Image size 1932x1916; FOV: 45 degrees.
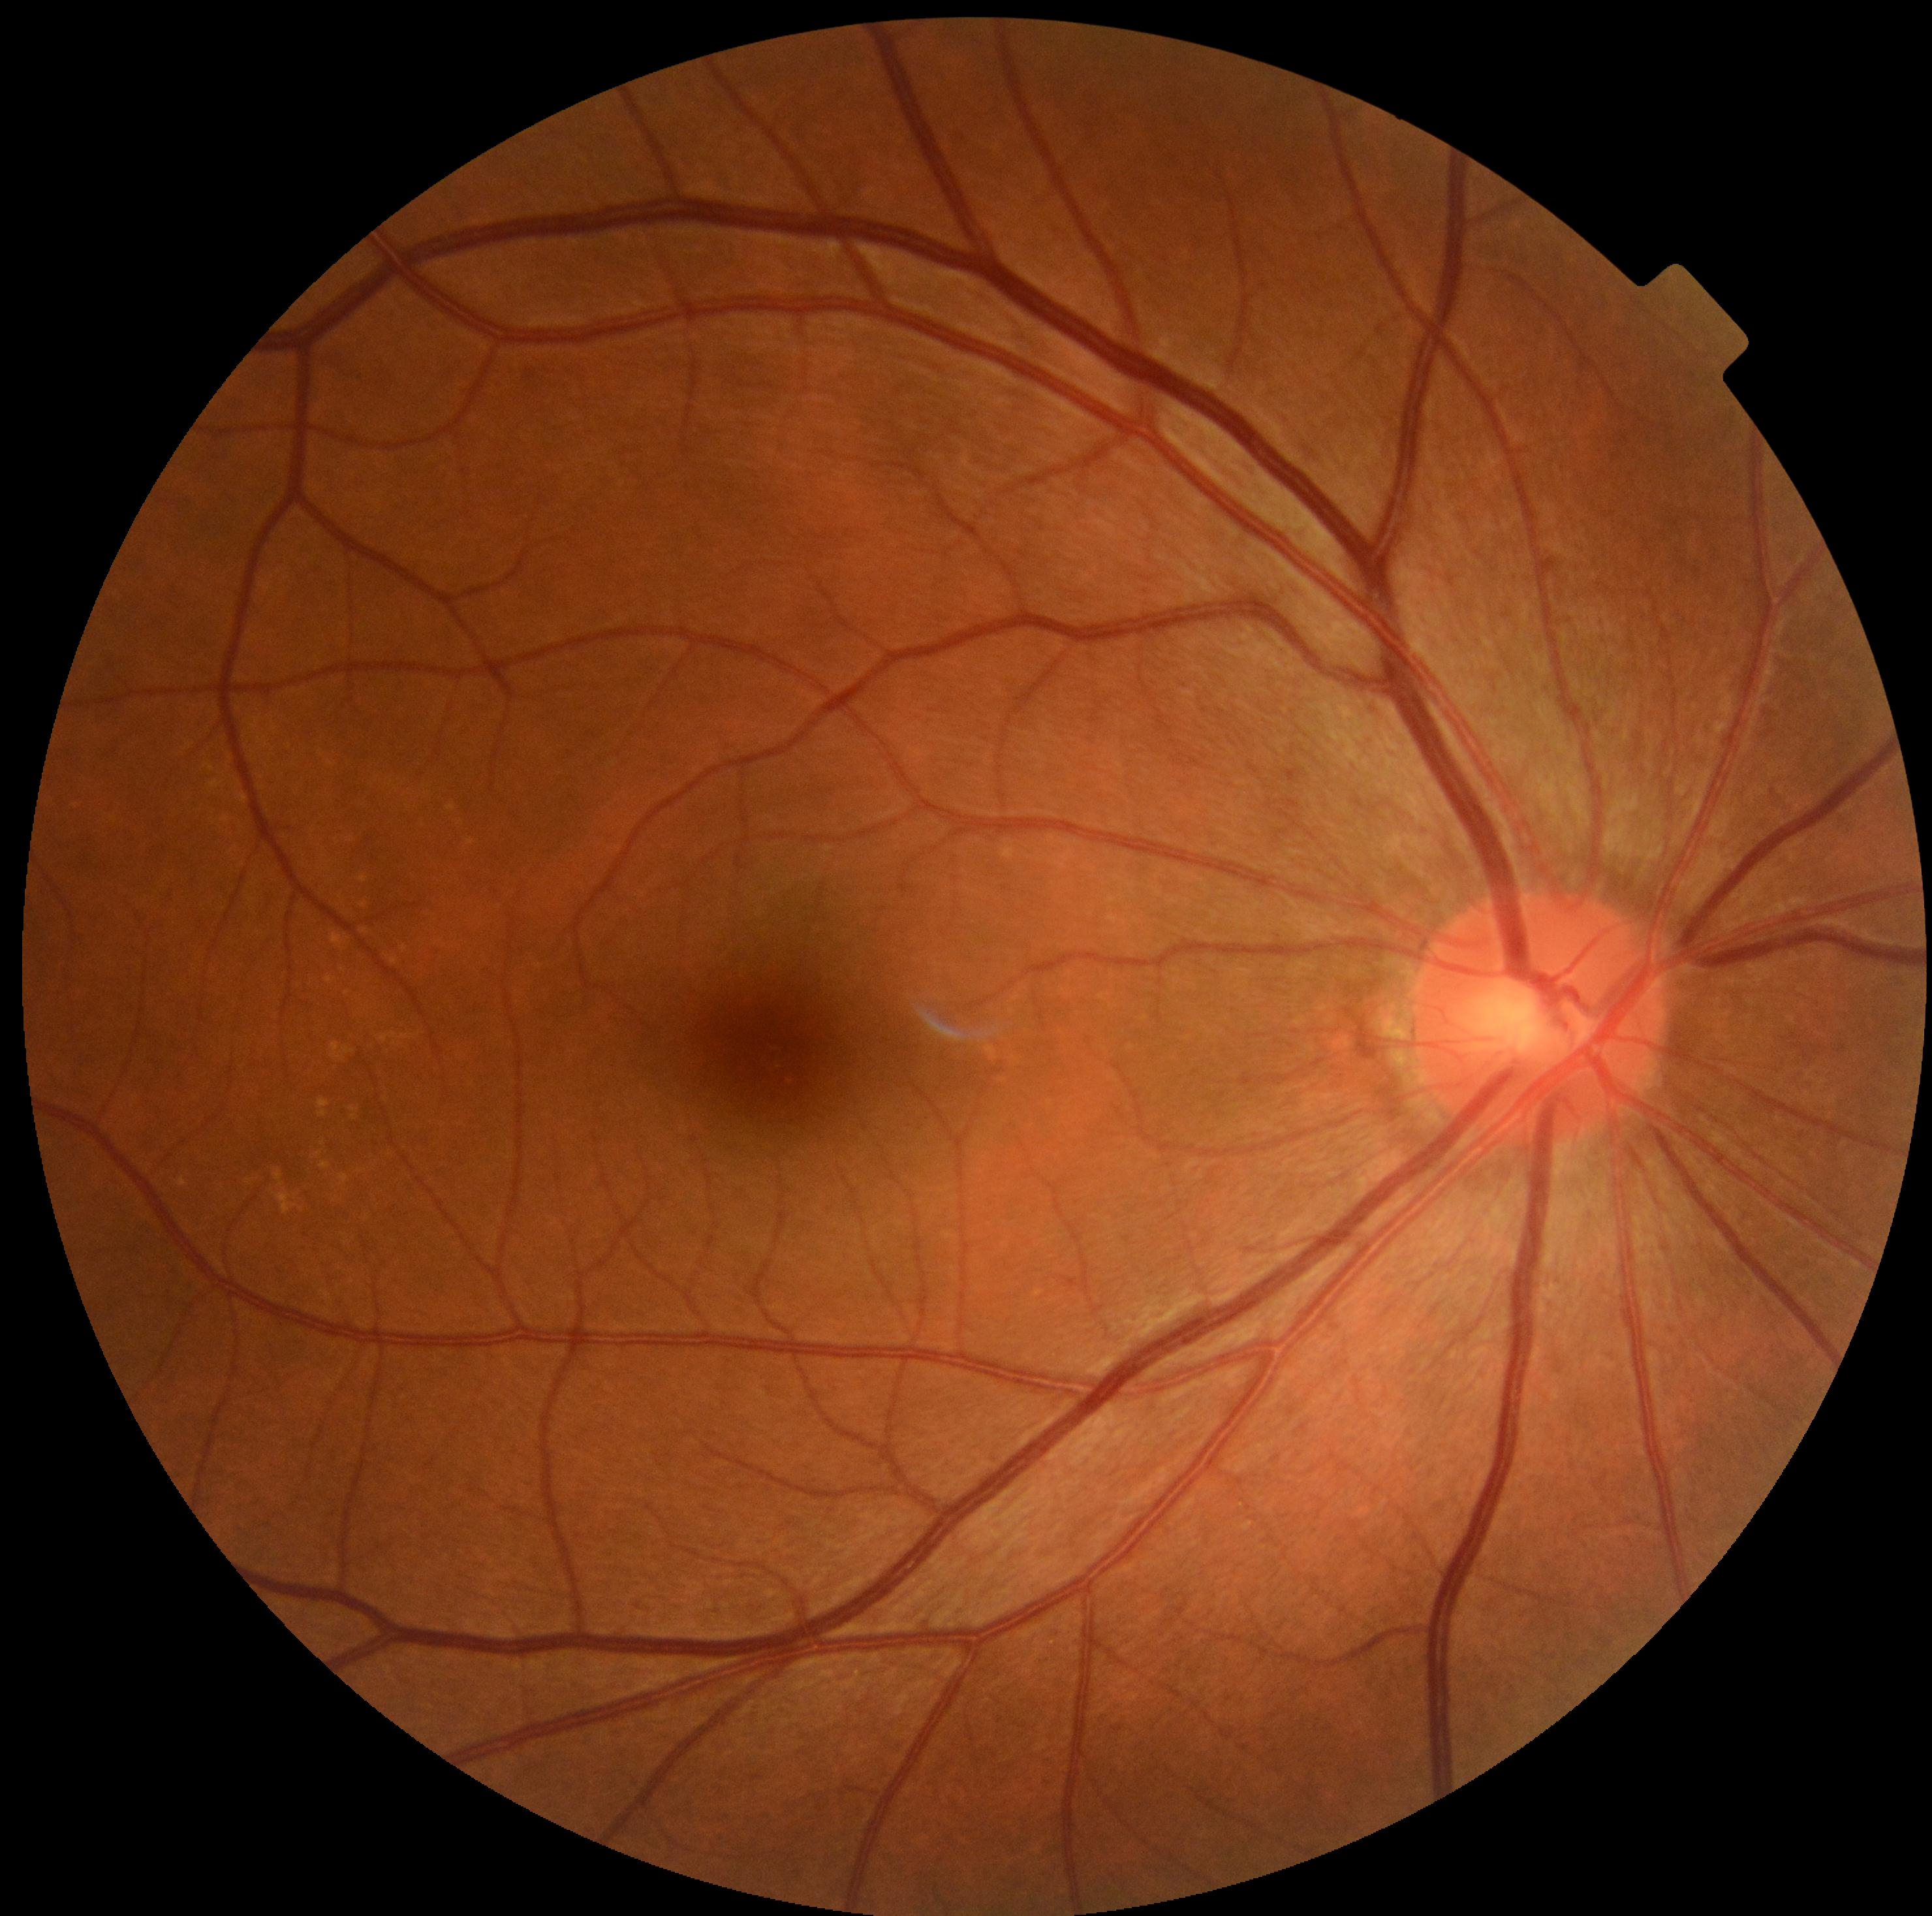 Diabetic retinopathy is grade 0.
No DR findings.